CFP · 2352 by 1568 pixels:
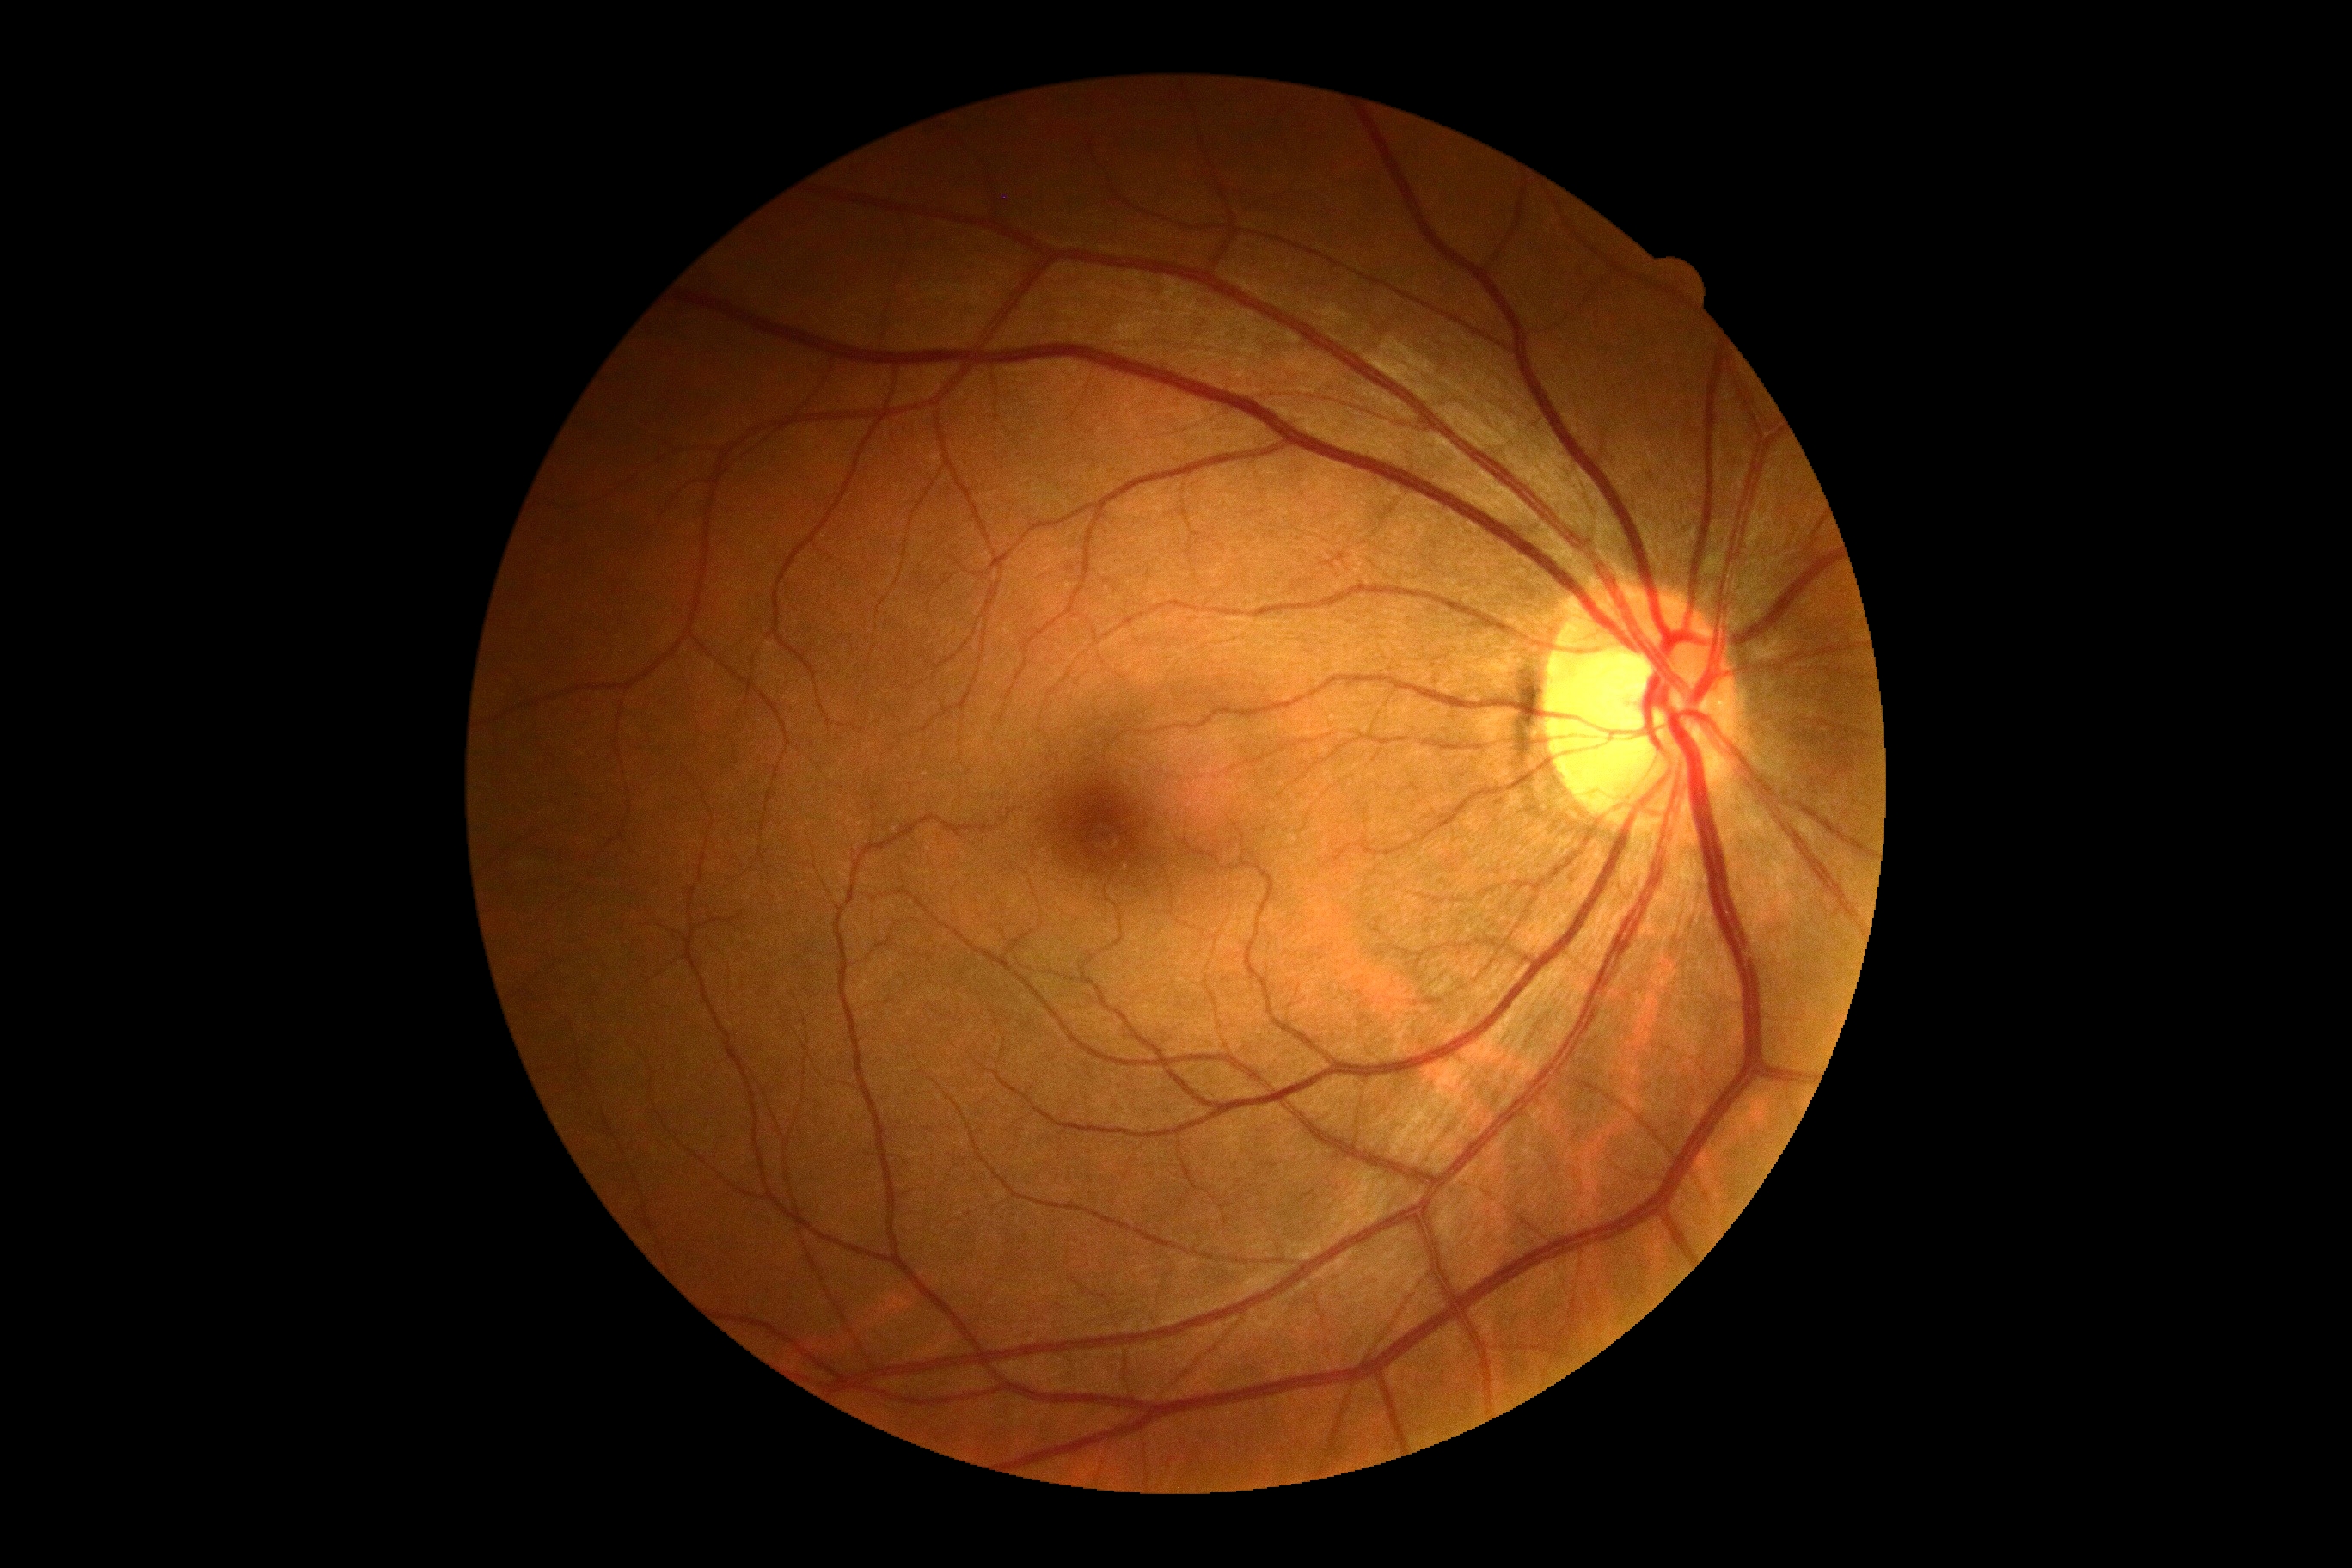 DR impression=no signs of DR, DR=no apparent retinopathy (grade 0).